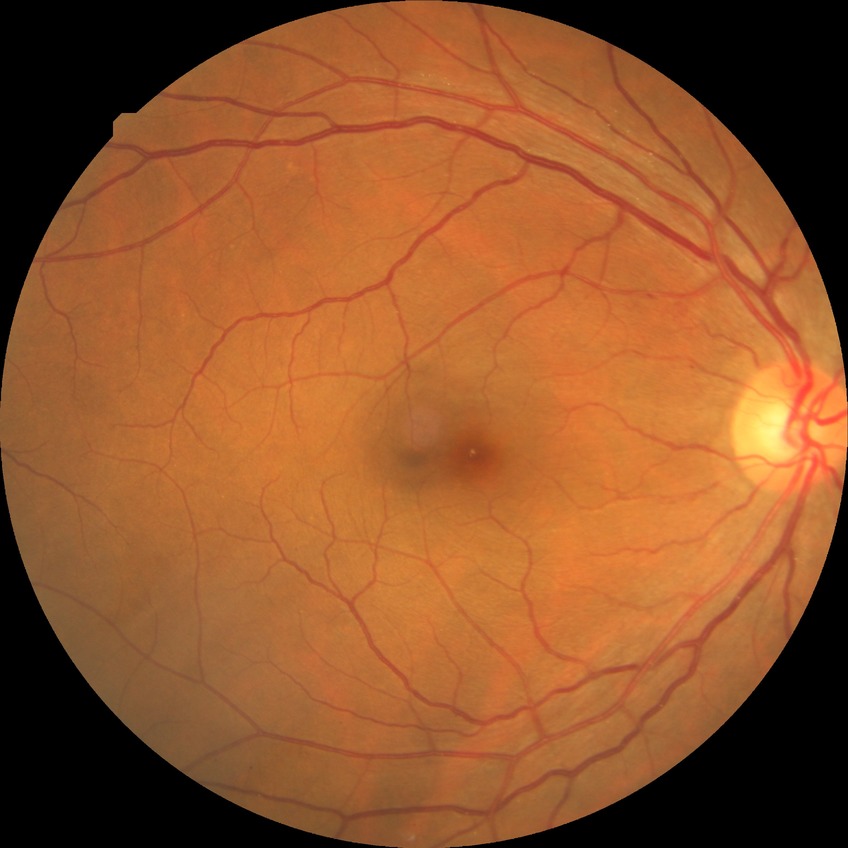
Diabetic retinopathy stage is simple diabetic retinopathy.